Wide-field contact fundus photograph of an infant.
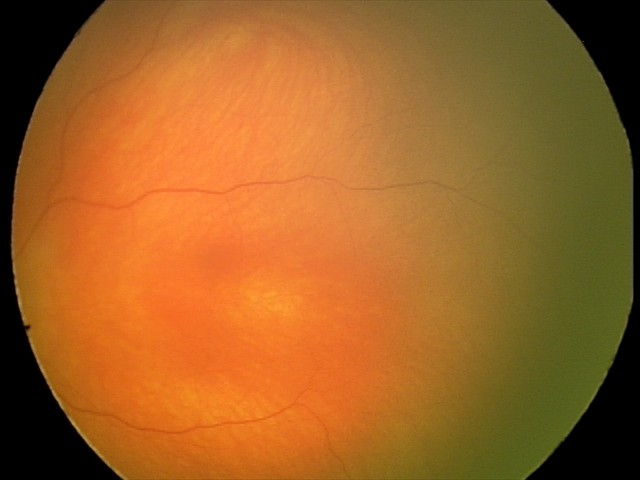

Examination with physiological retinal findings.